ONH-centered crop from a color fundus image. Mydriatic acquisition.
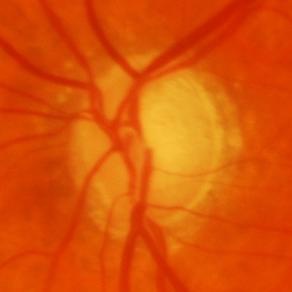
Glaucoma assessment: glaucomatous damage to the optic nerve.